2352 x 1568 pixels. Color fundus photograph. 45° FOV
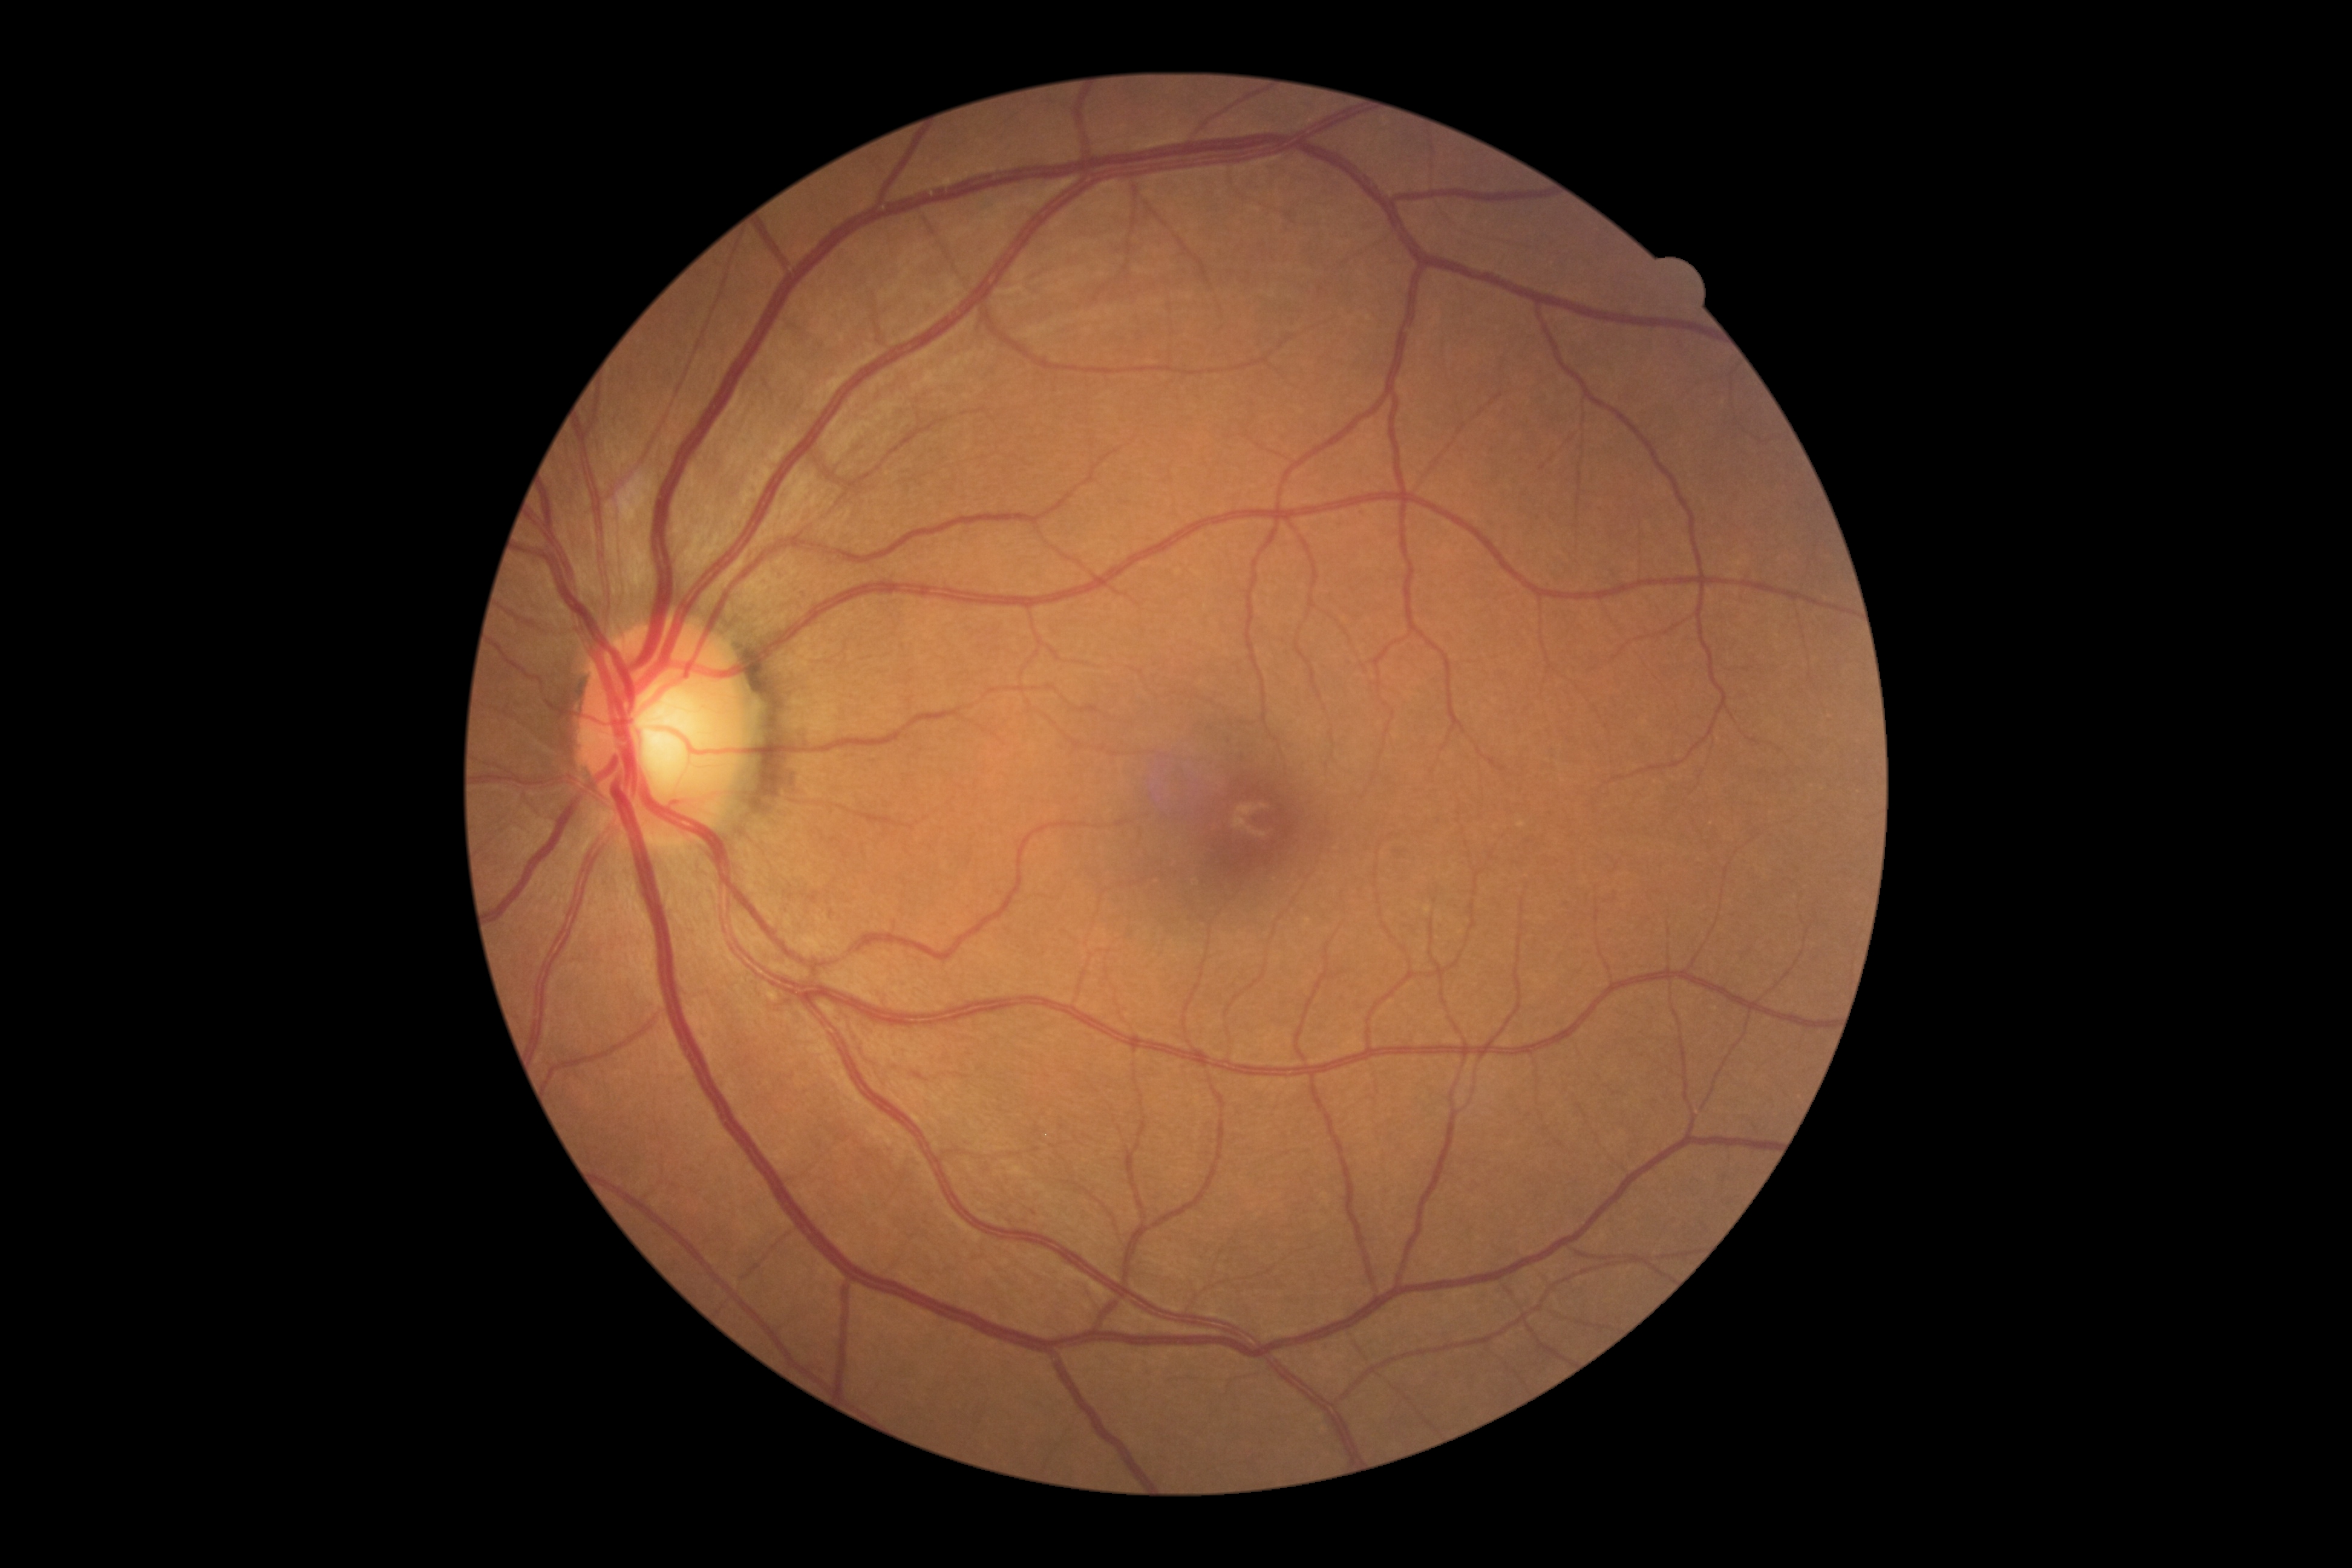

diabetic retinopathy severity: no apparent retinopathy (grade 0); DR impression: no signs of DR.